Ultra-widefield fundus photograph: 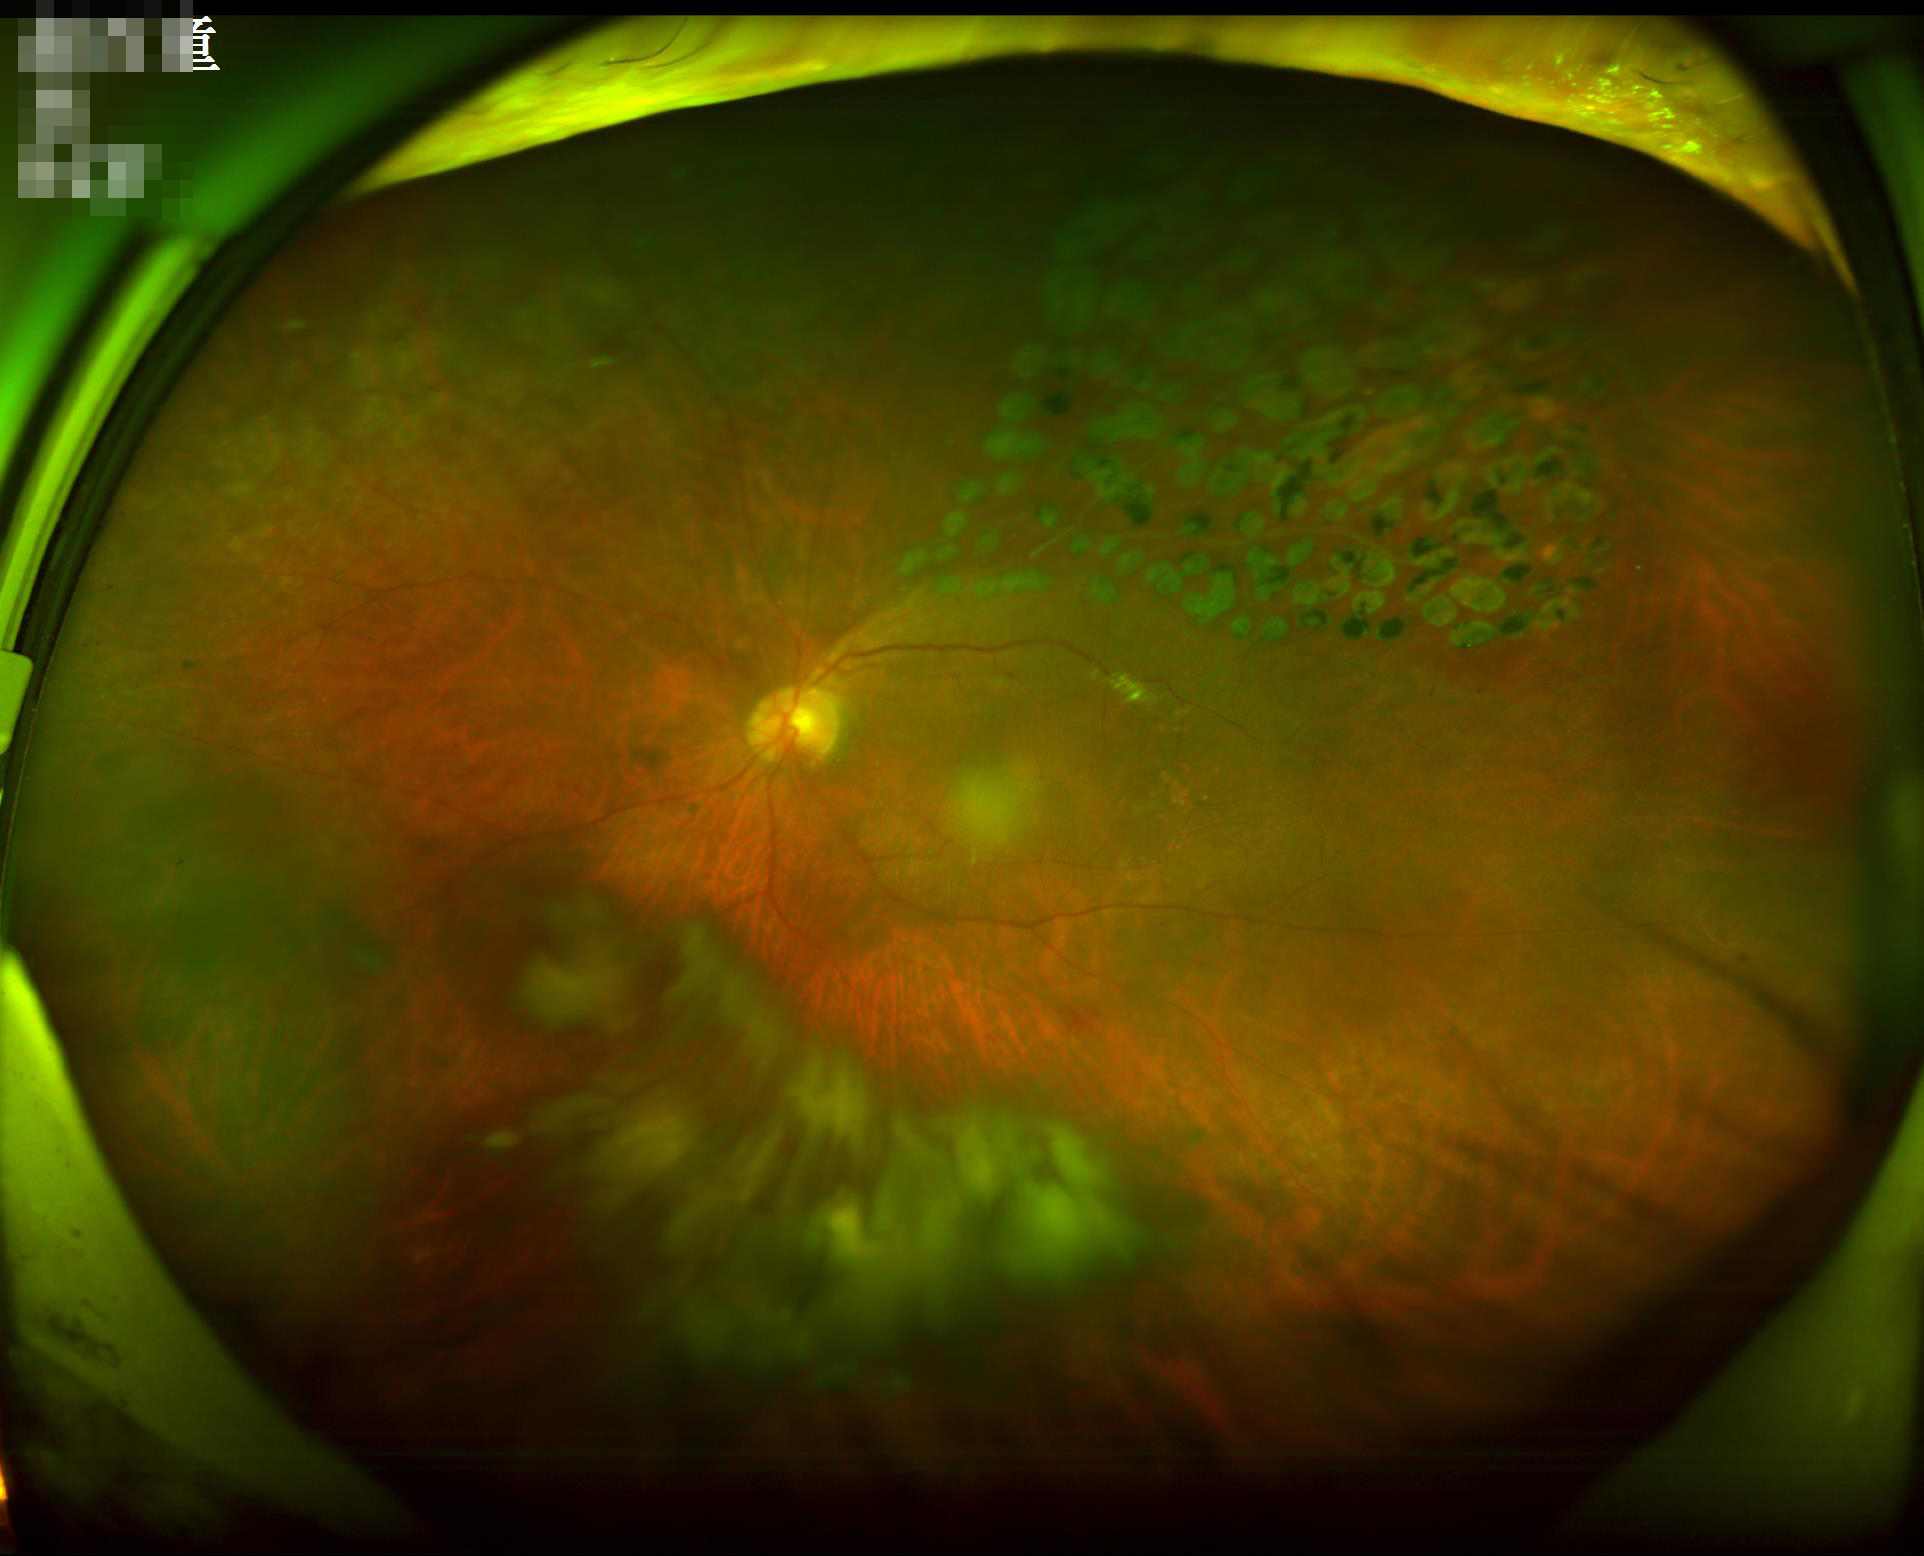
The image is blurry.
Vessels and details are readily distinguishable.
Image quality is inadequate for diagnostic use.
Poor illumination with uneven exposure.